1659 x 2212 pixels, acquired with a Remidio Fundus on Phone (FOP) camera, fundus photo:
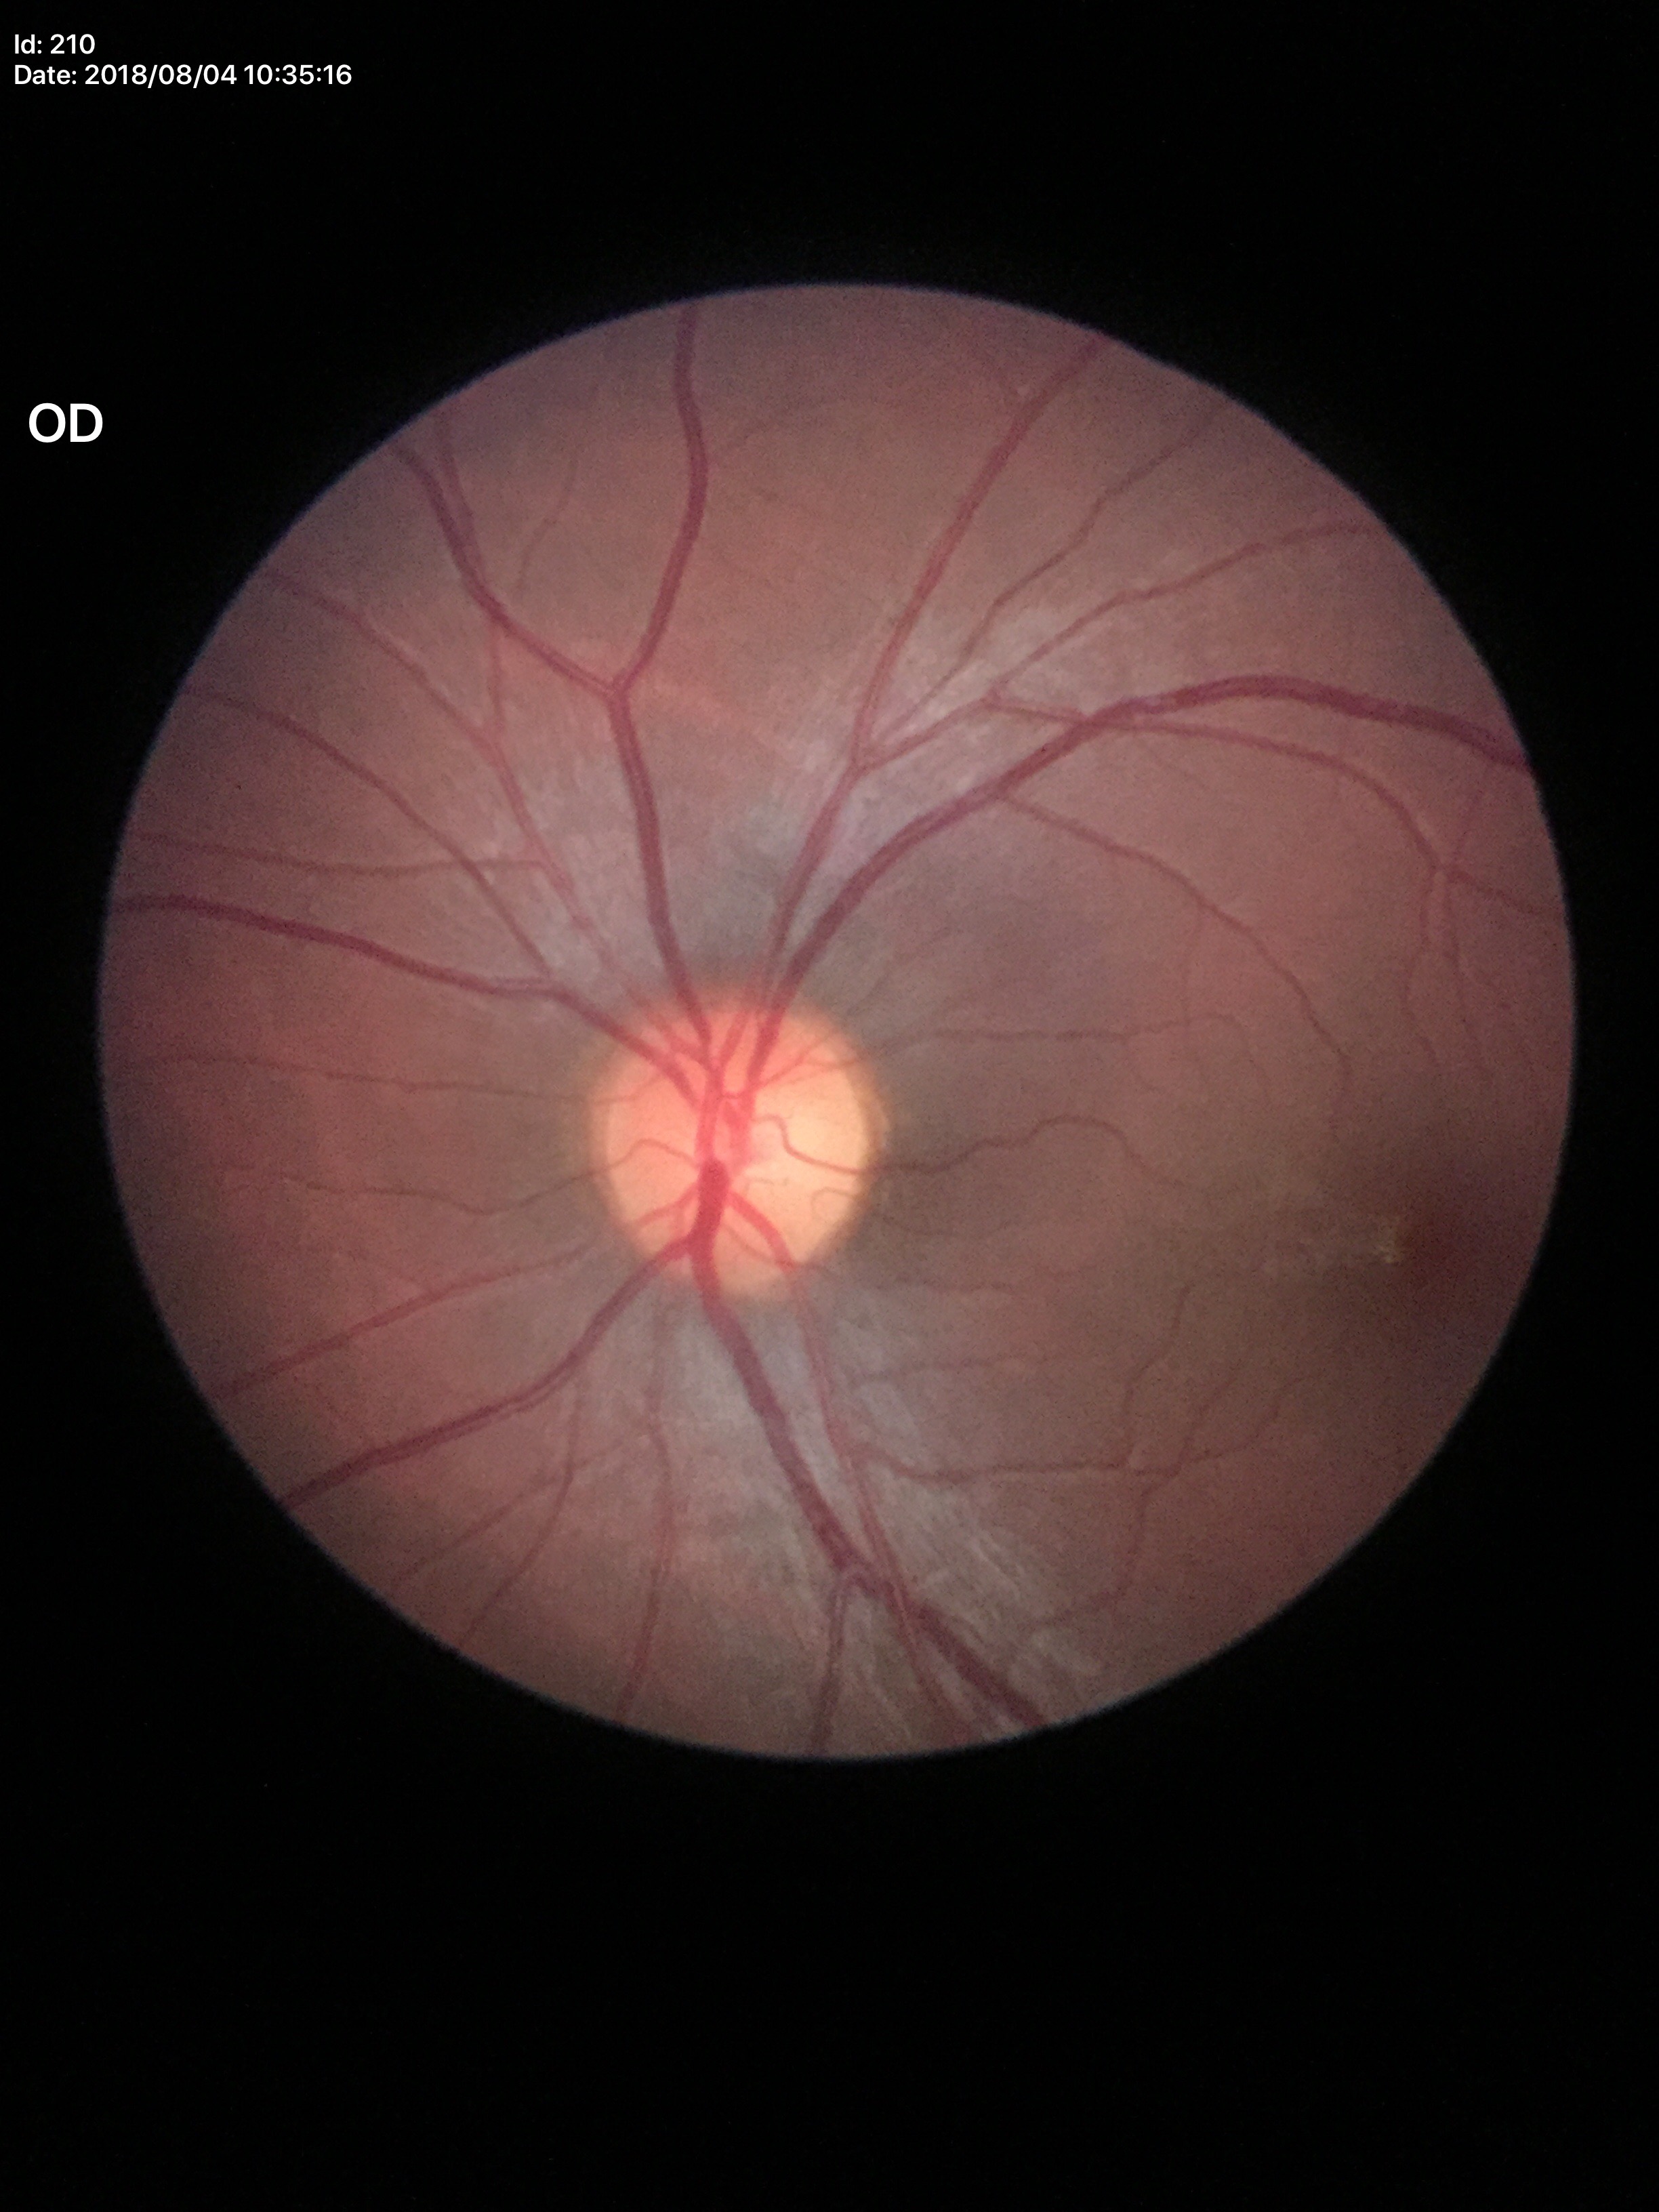 Glaucoma assessment: negative.
VCDR is 0.52.